Image size 2184x1690; CFP.
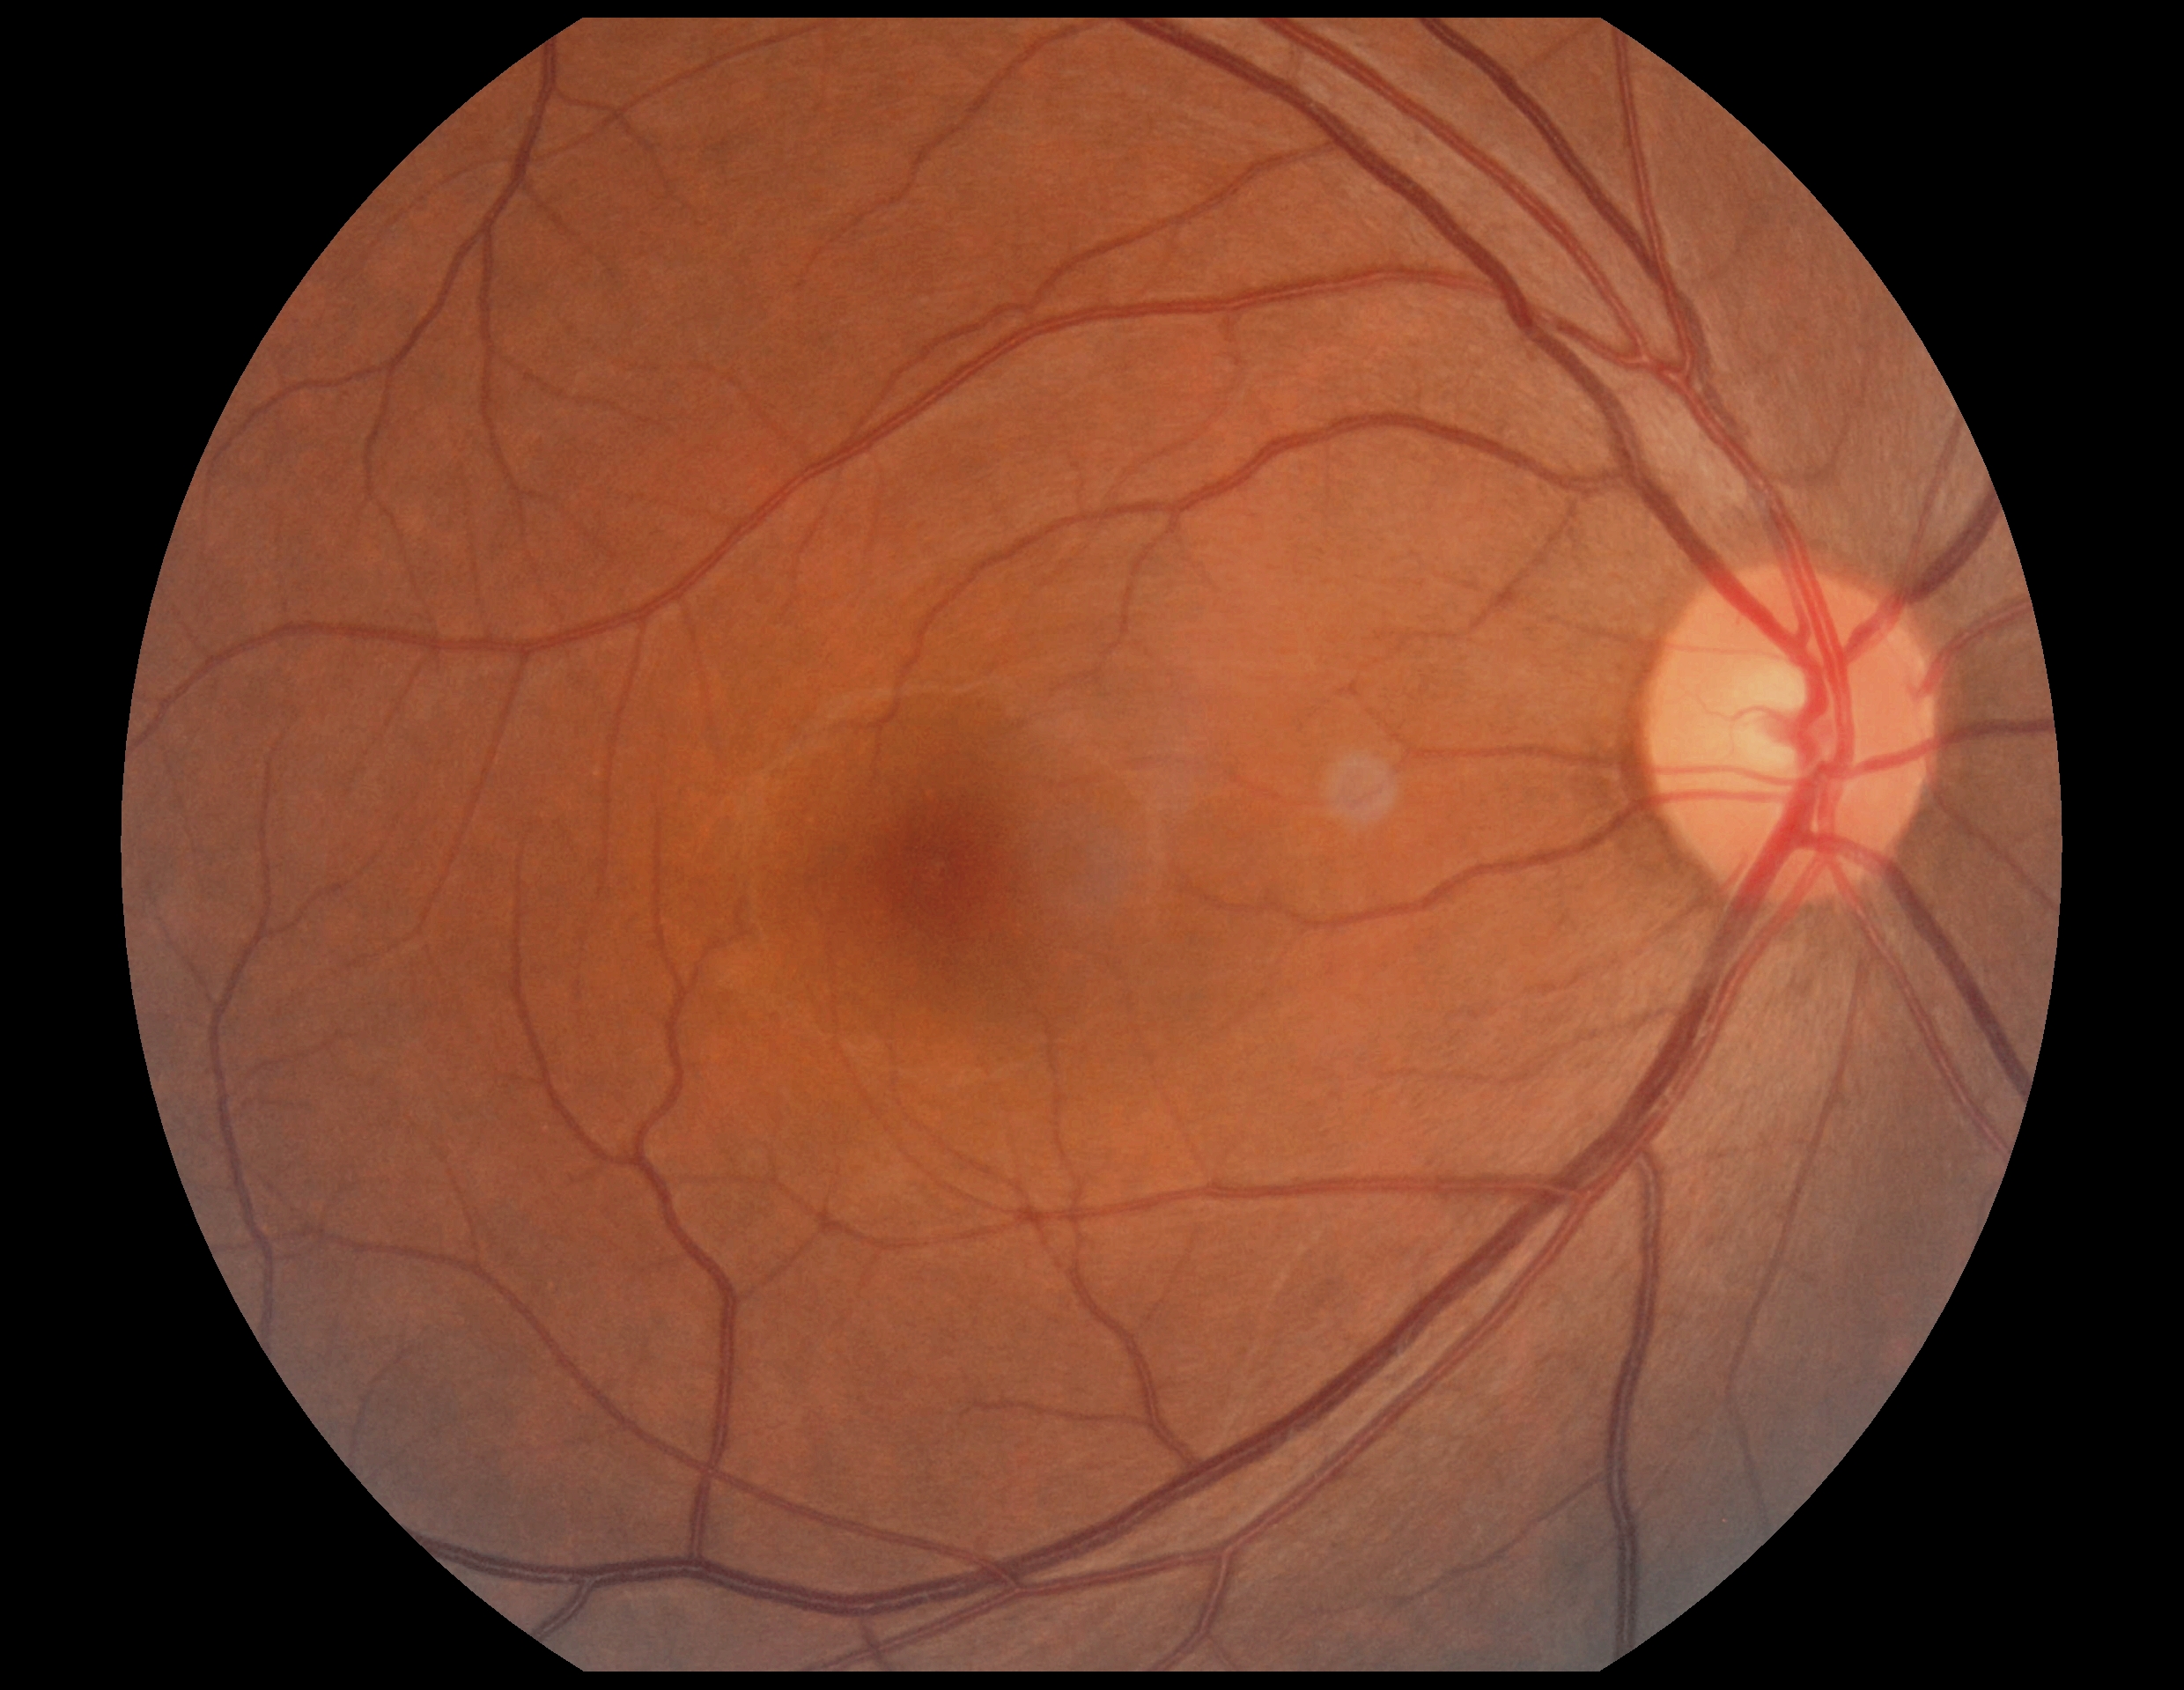 No DR findings.
DR: 0 — no visible signs of diabetic retinopathy.